Wide-field fundus photograph from neonatal ROP screening; 1240 by 1240 pixels.
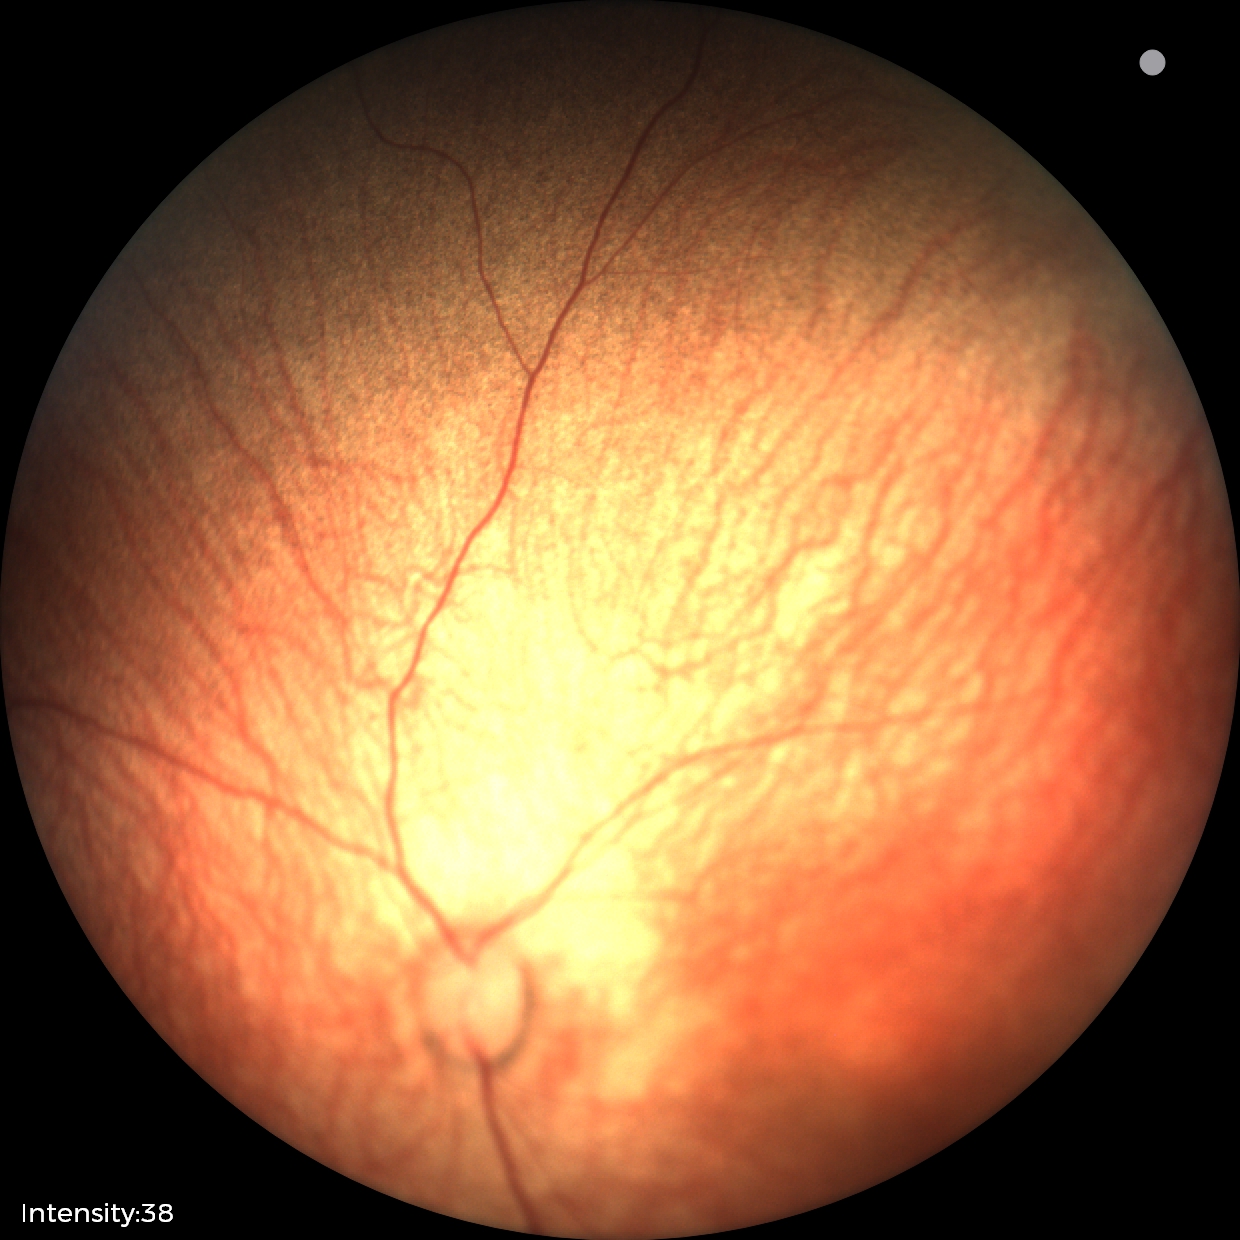 Physiological retinal appearance for postconceptual age.